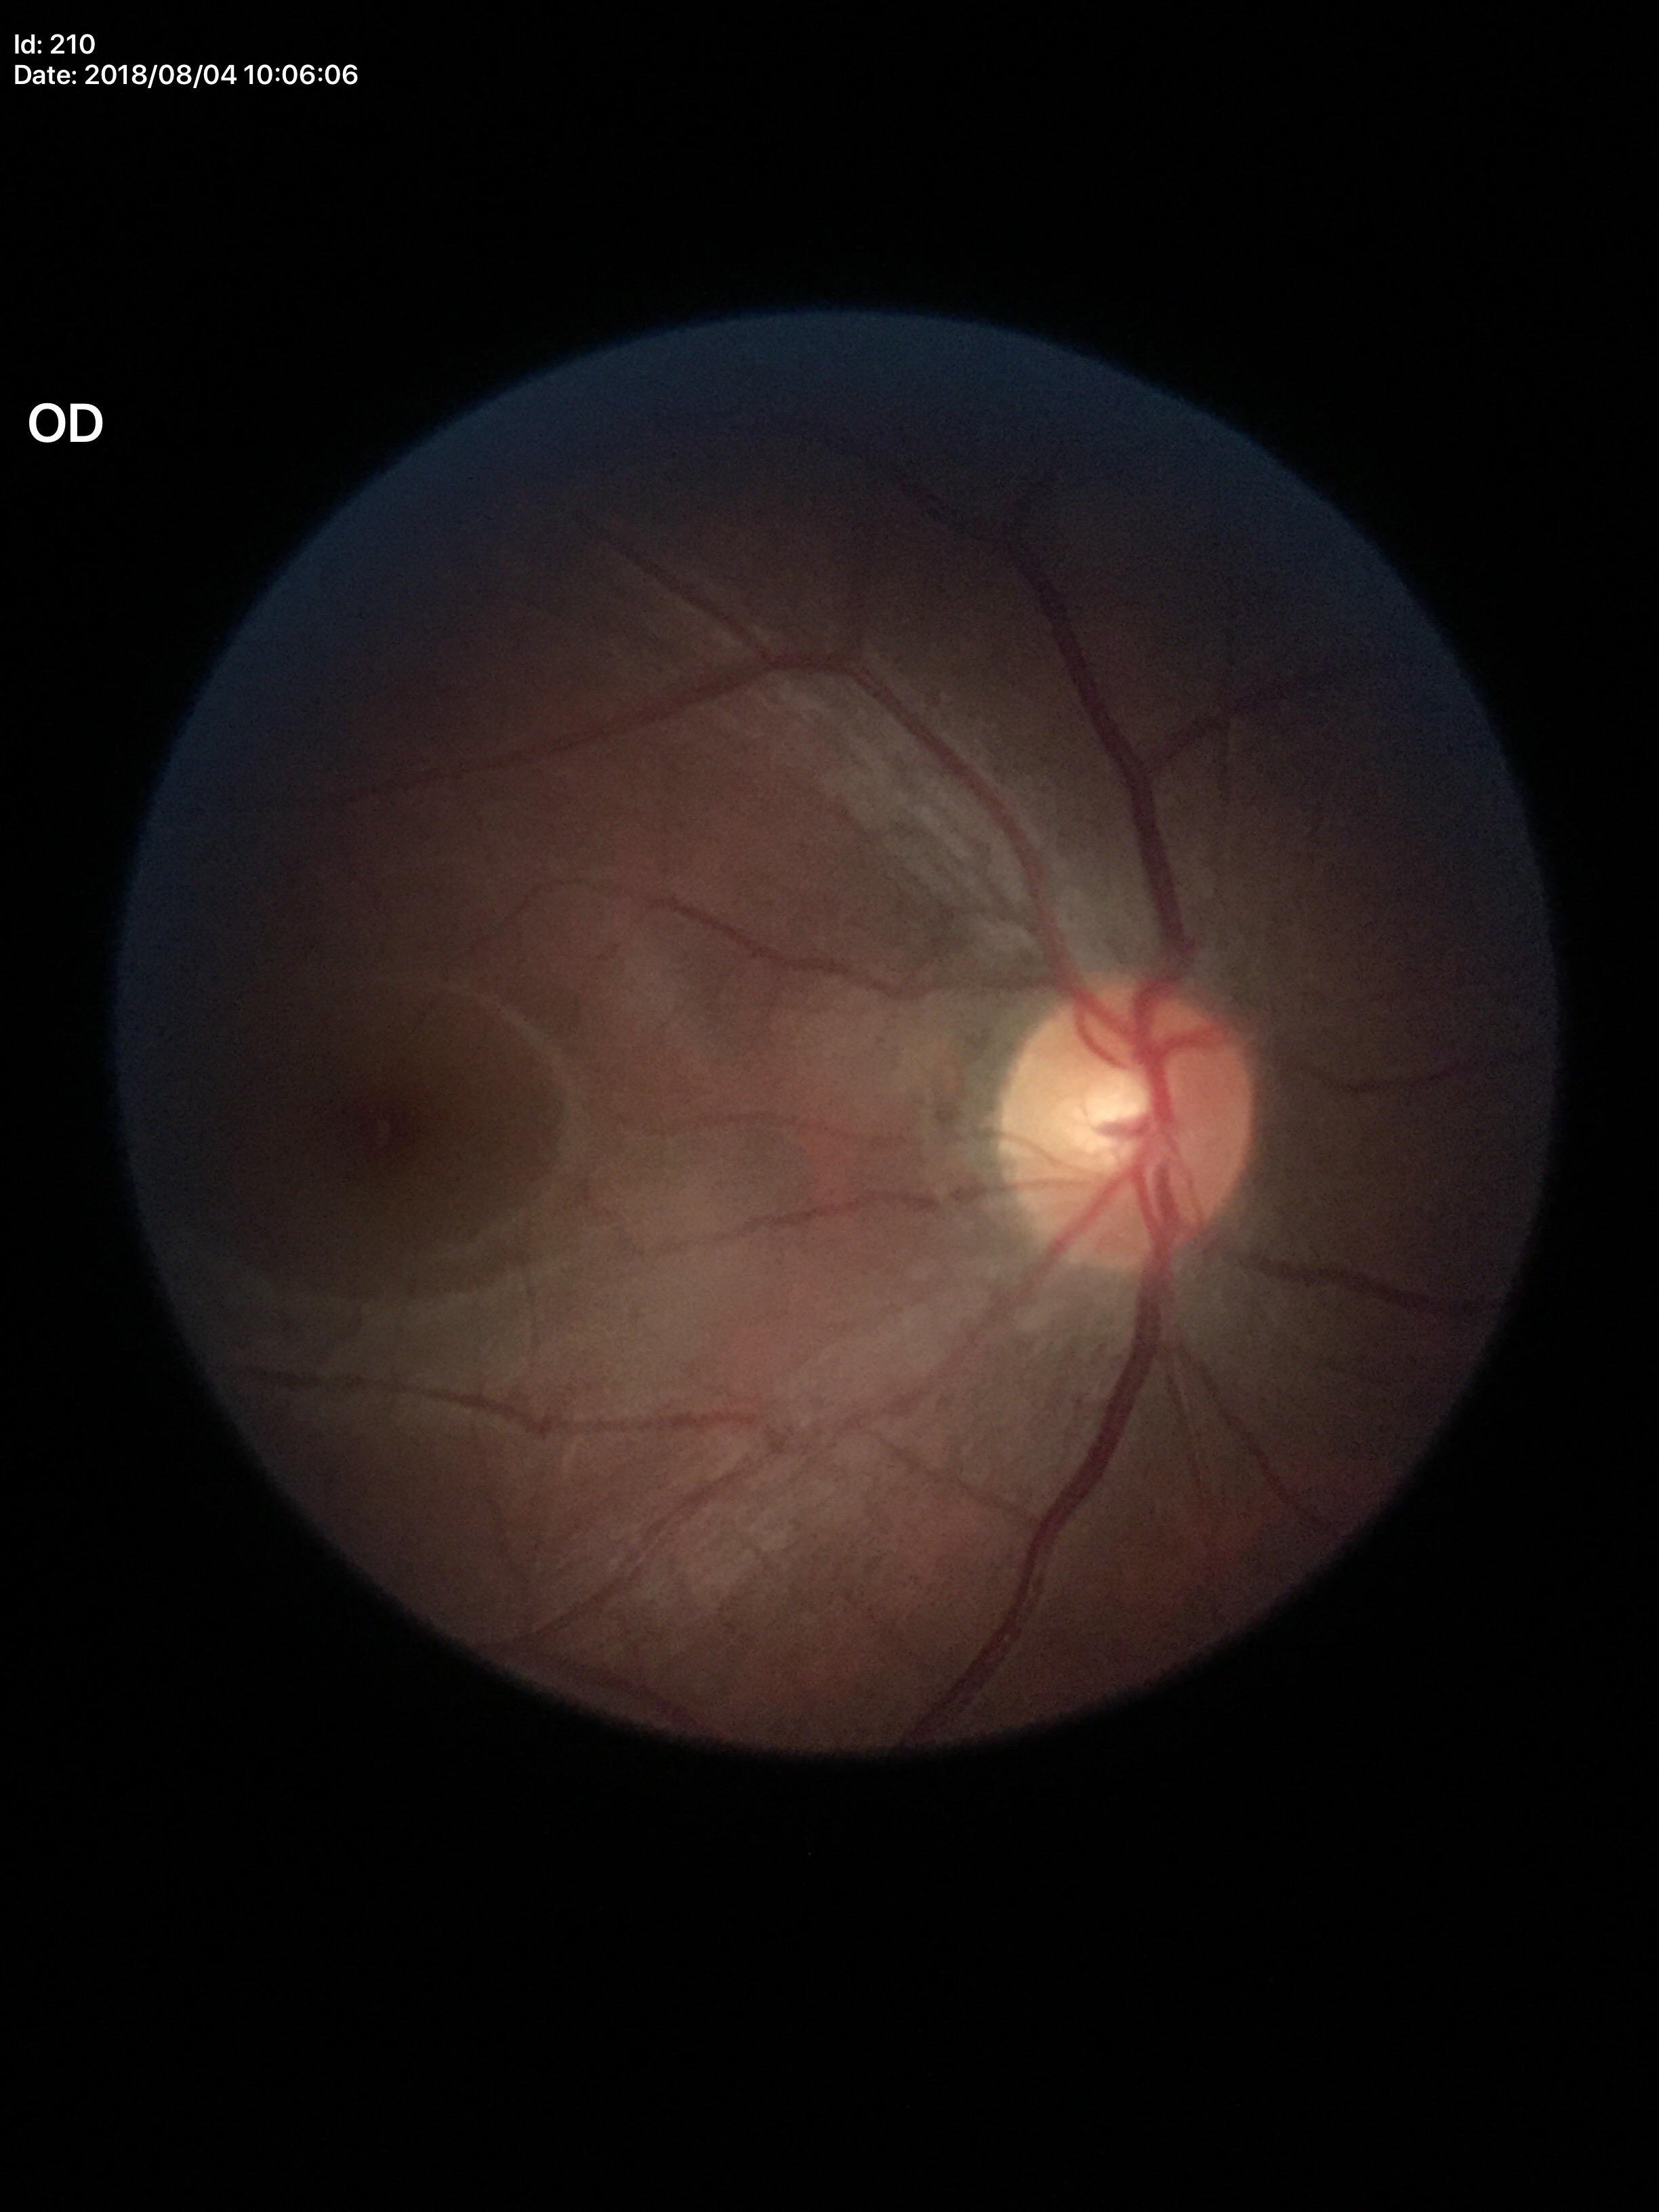 Glaucoma evaluation: no suspicious findings (unanimous normal call). Vertical C/D ratio of 0.49.